45° field of view; 2352 x 1568 pixels; color fundus photograph — 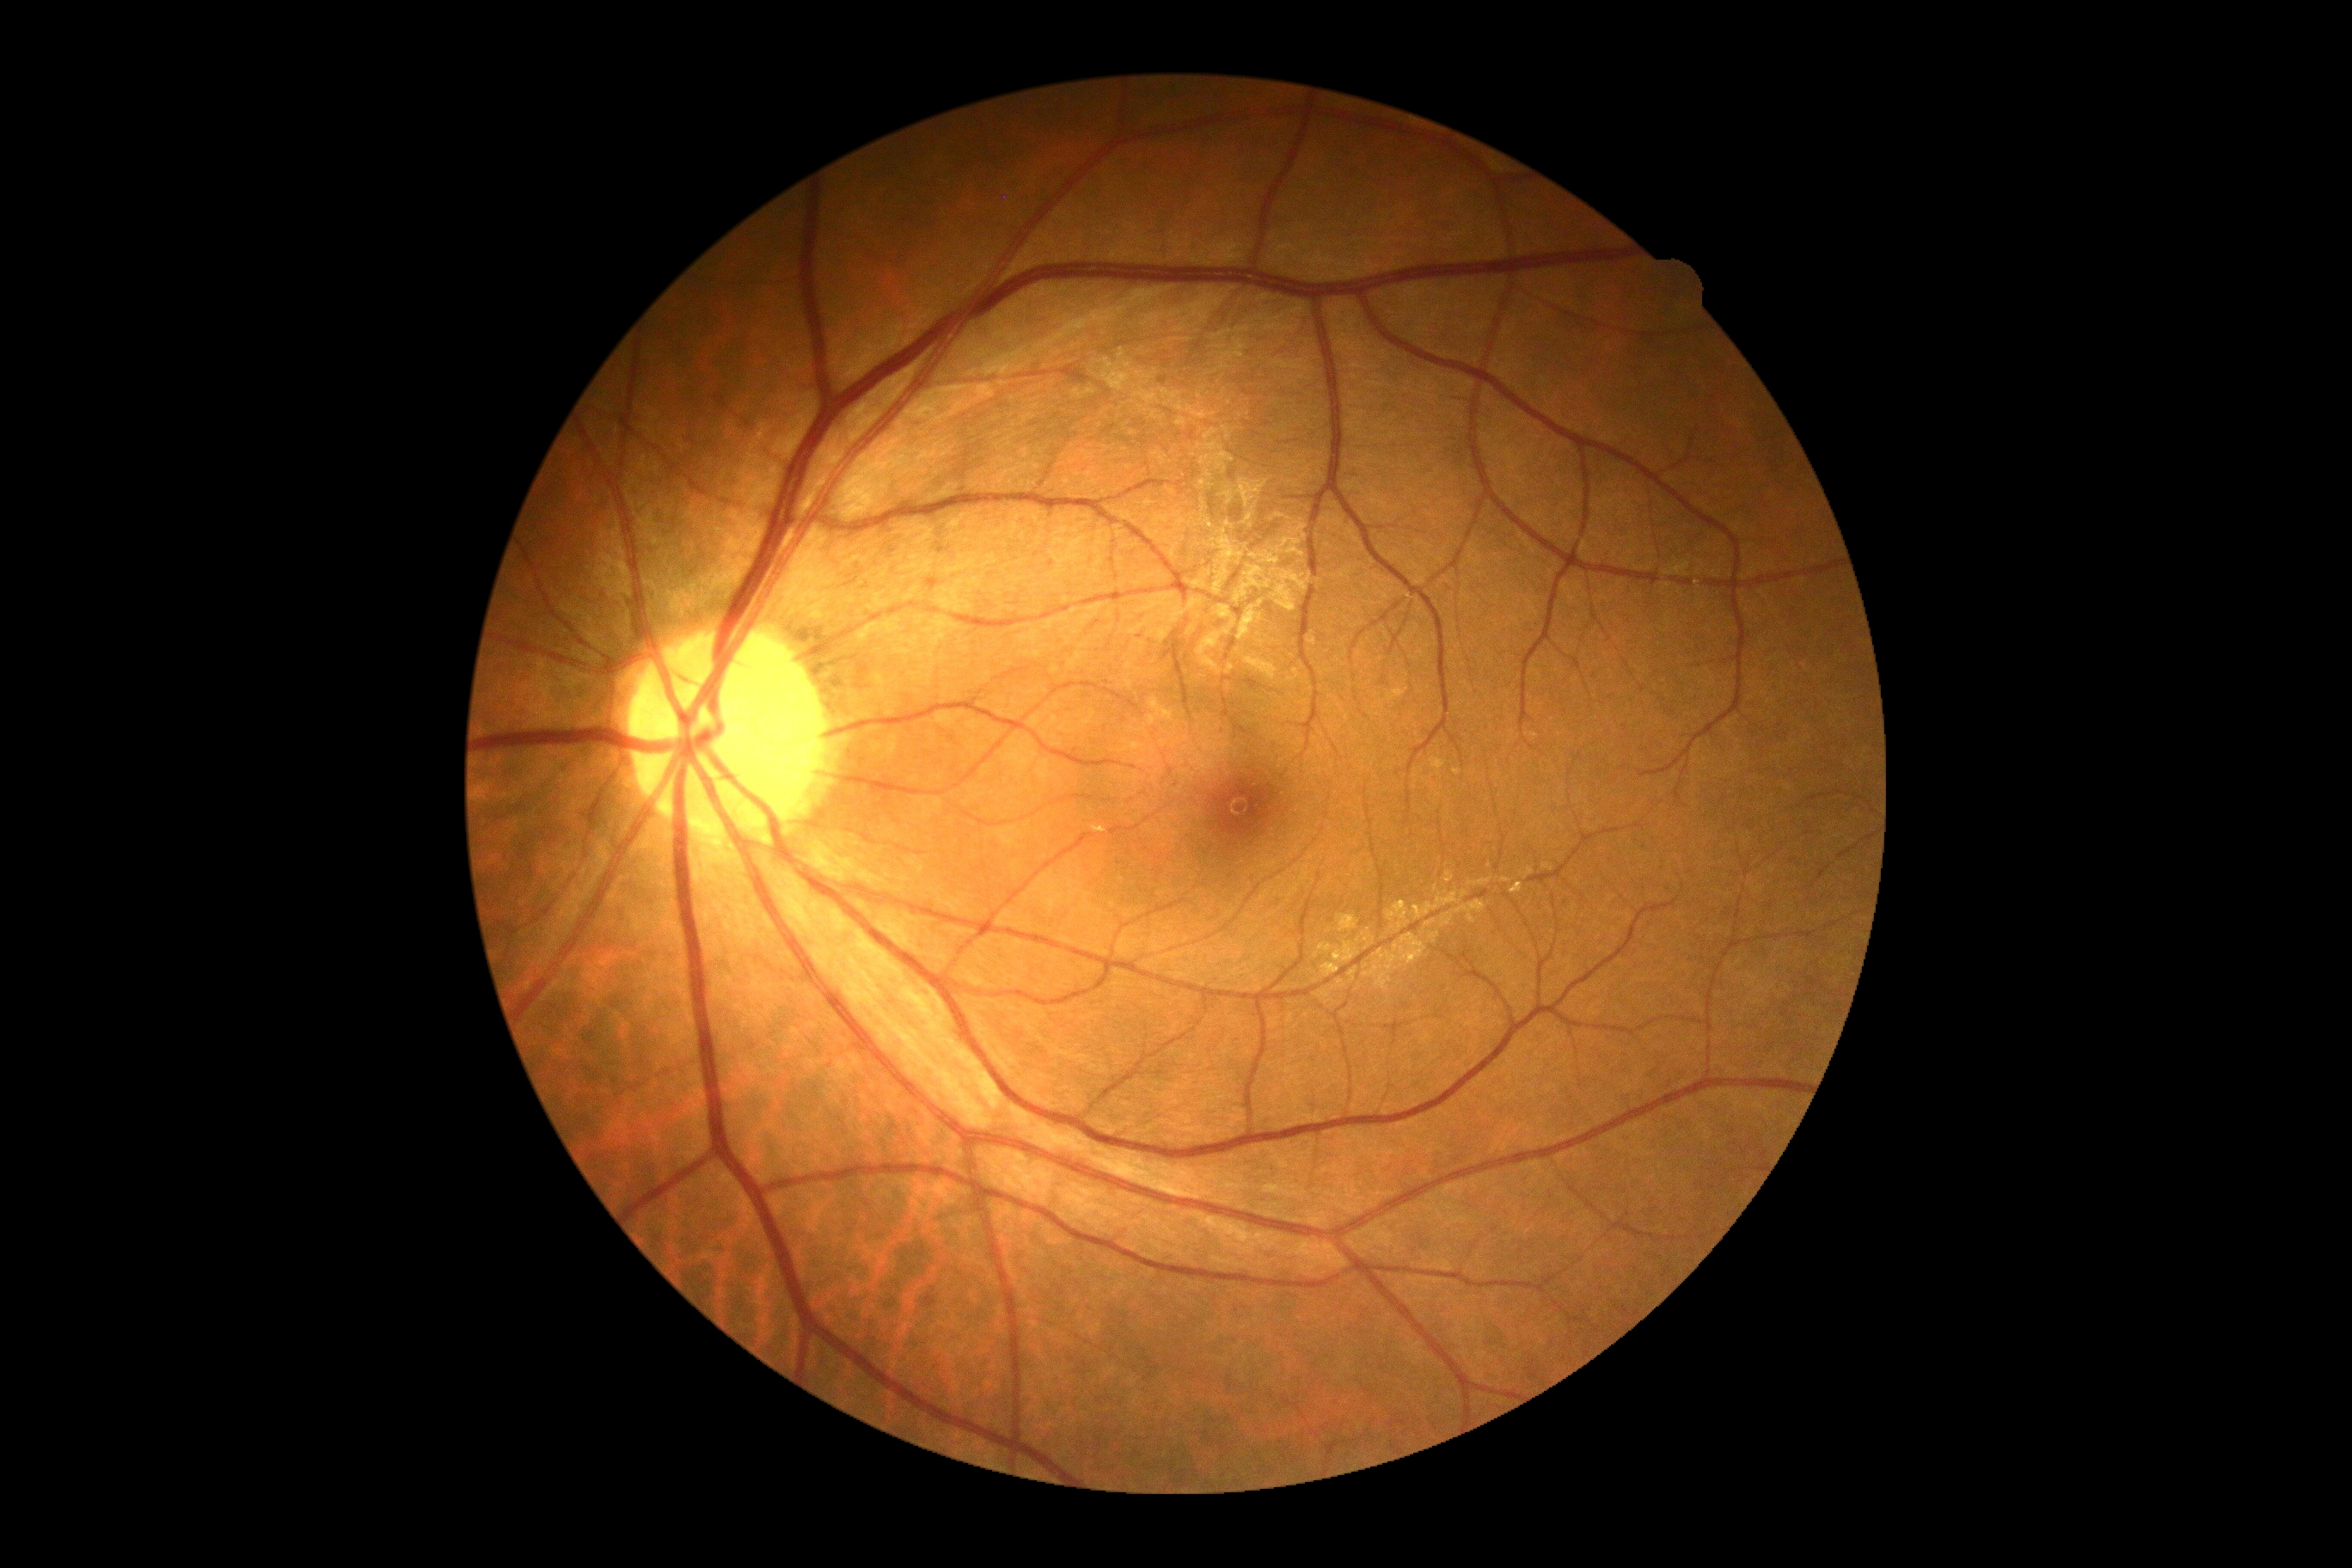

No signs of diabetic retinopathy.
Diabetic retinopathy: grade 0 (no apparent retinopathy).